45° FOV. 2352x1568px
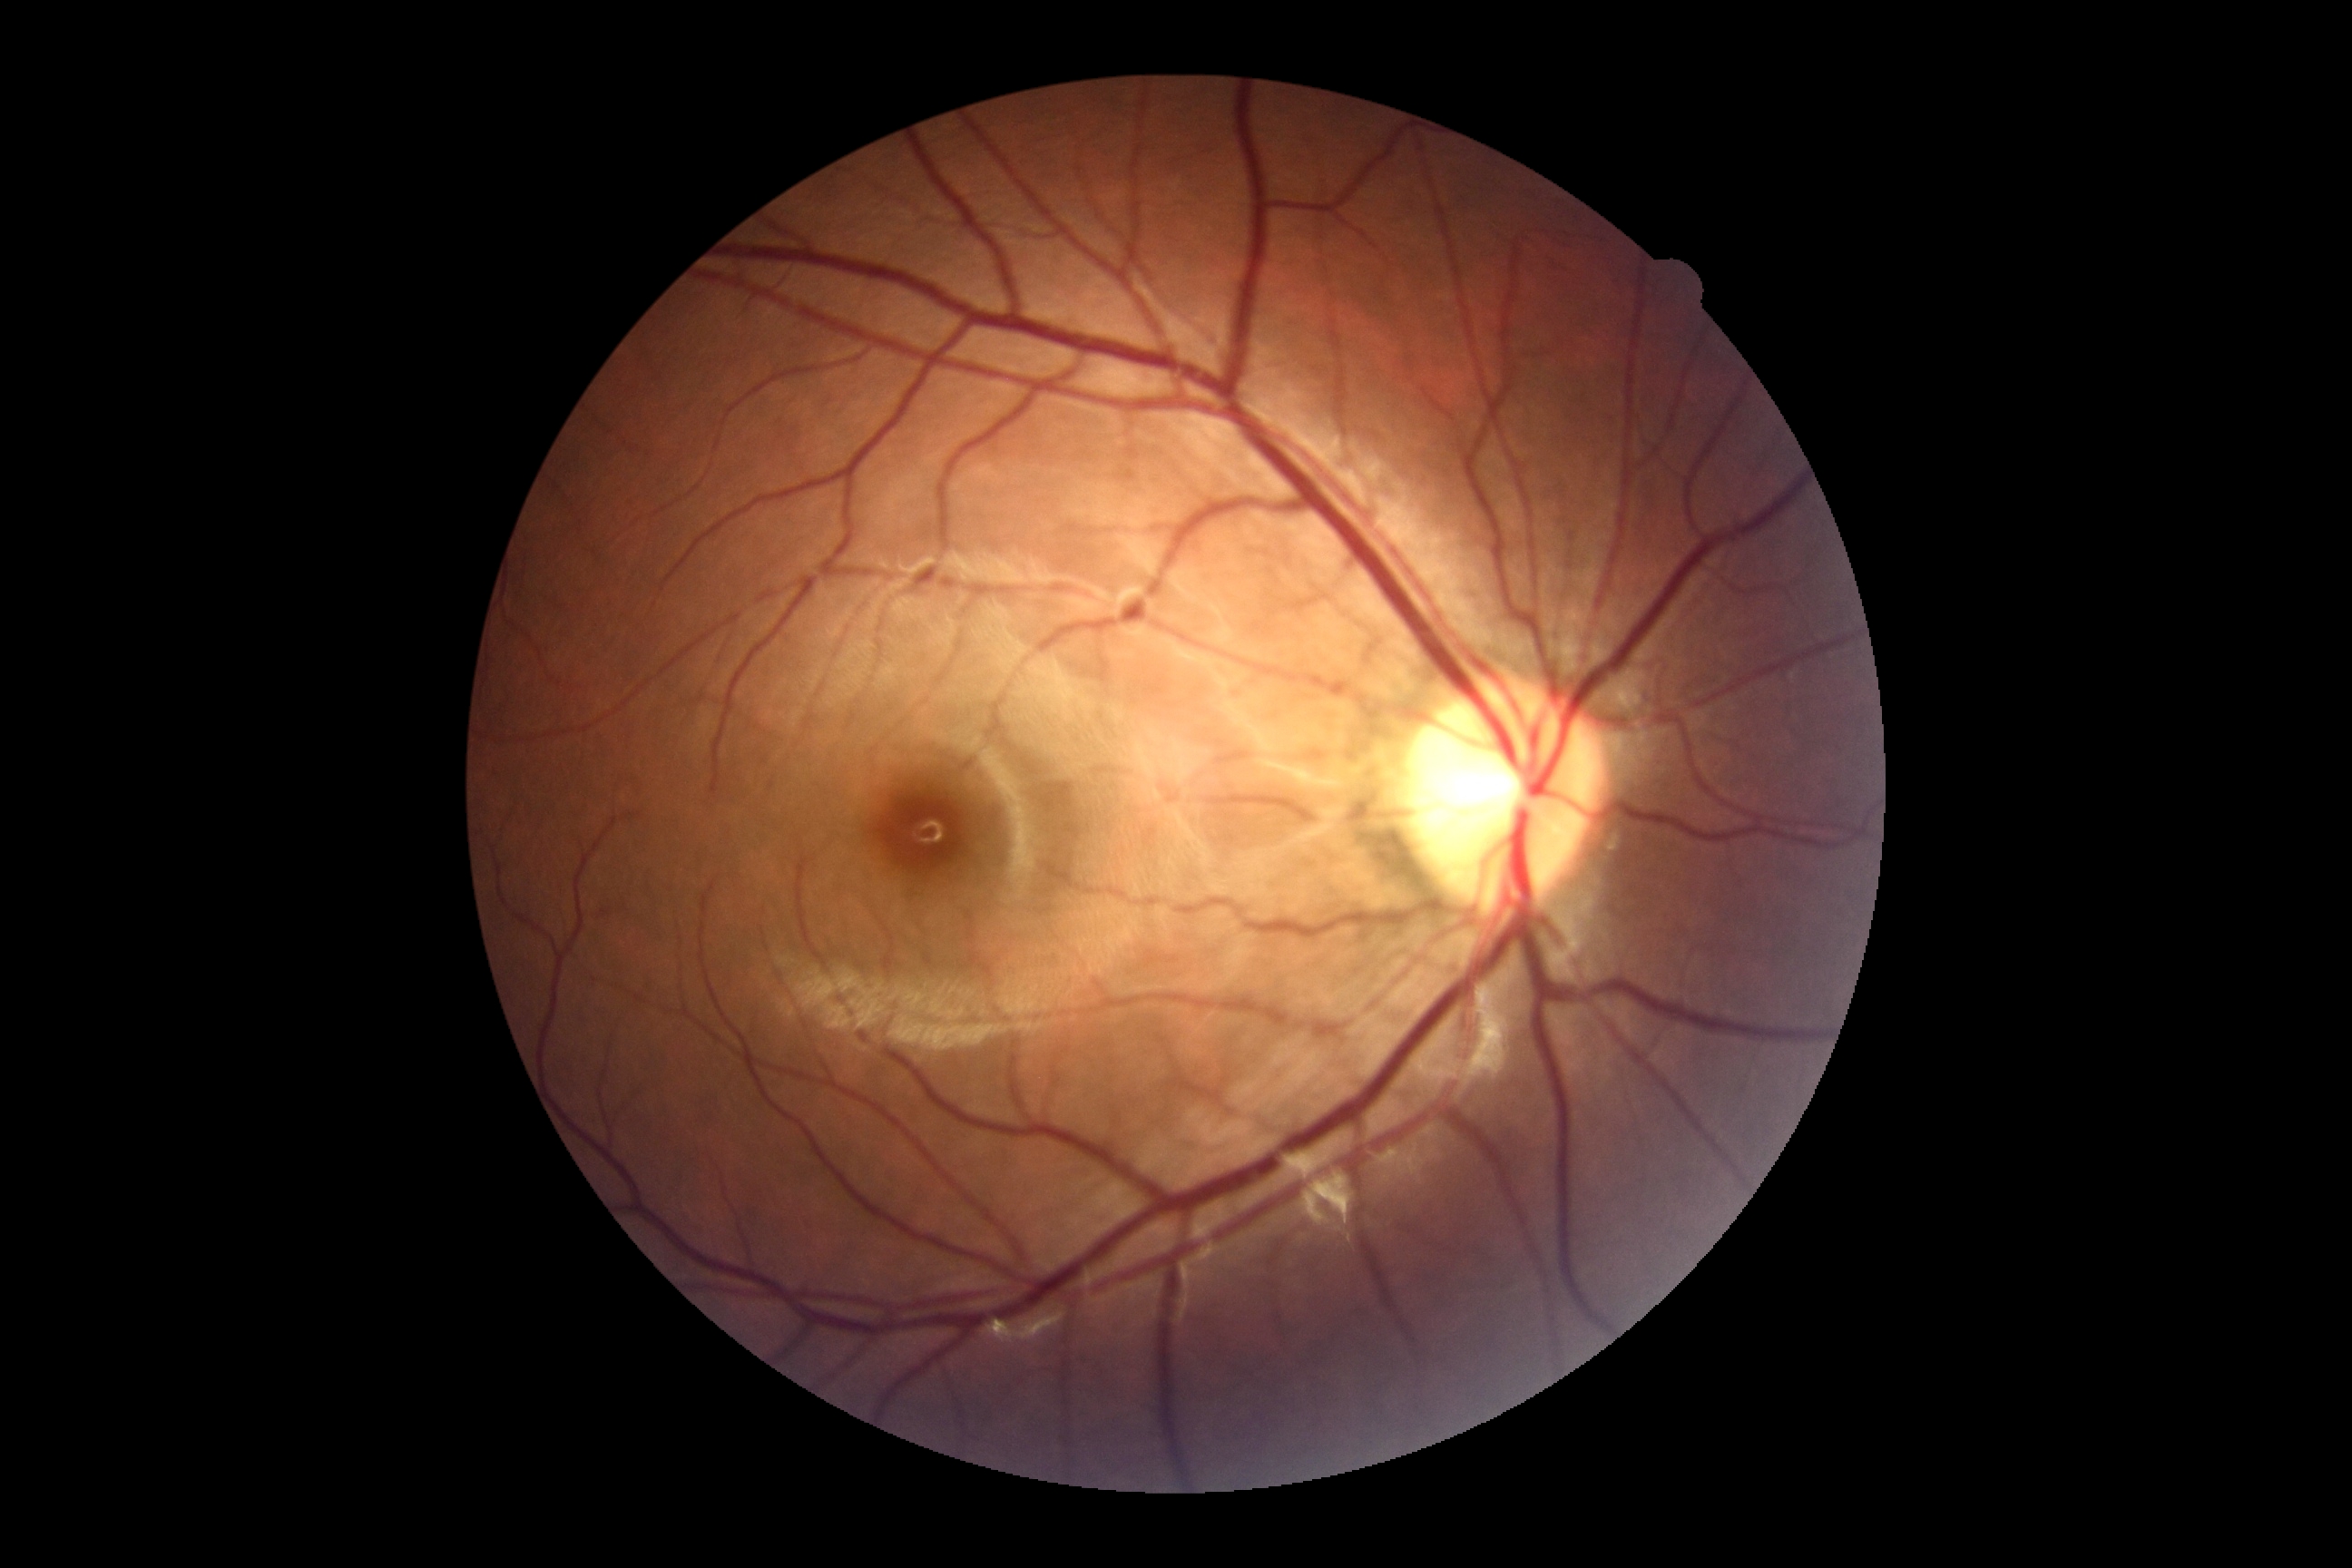

  dr_grade: 0/4